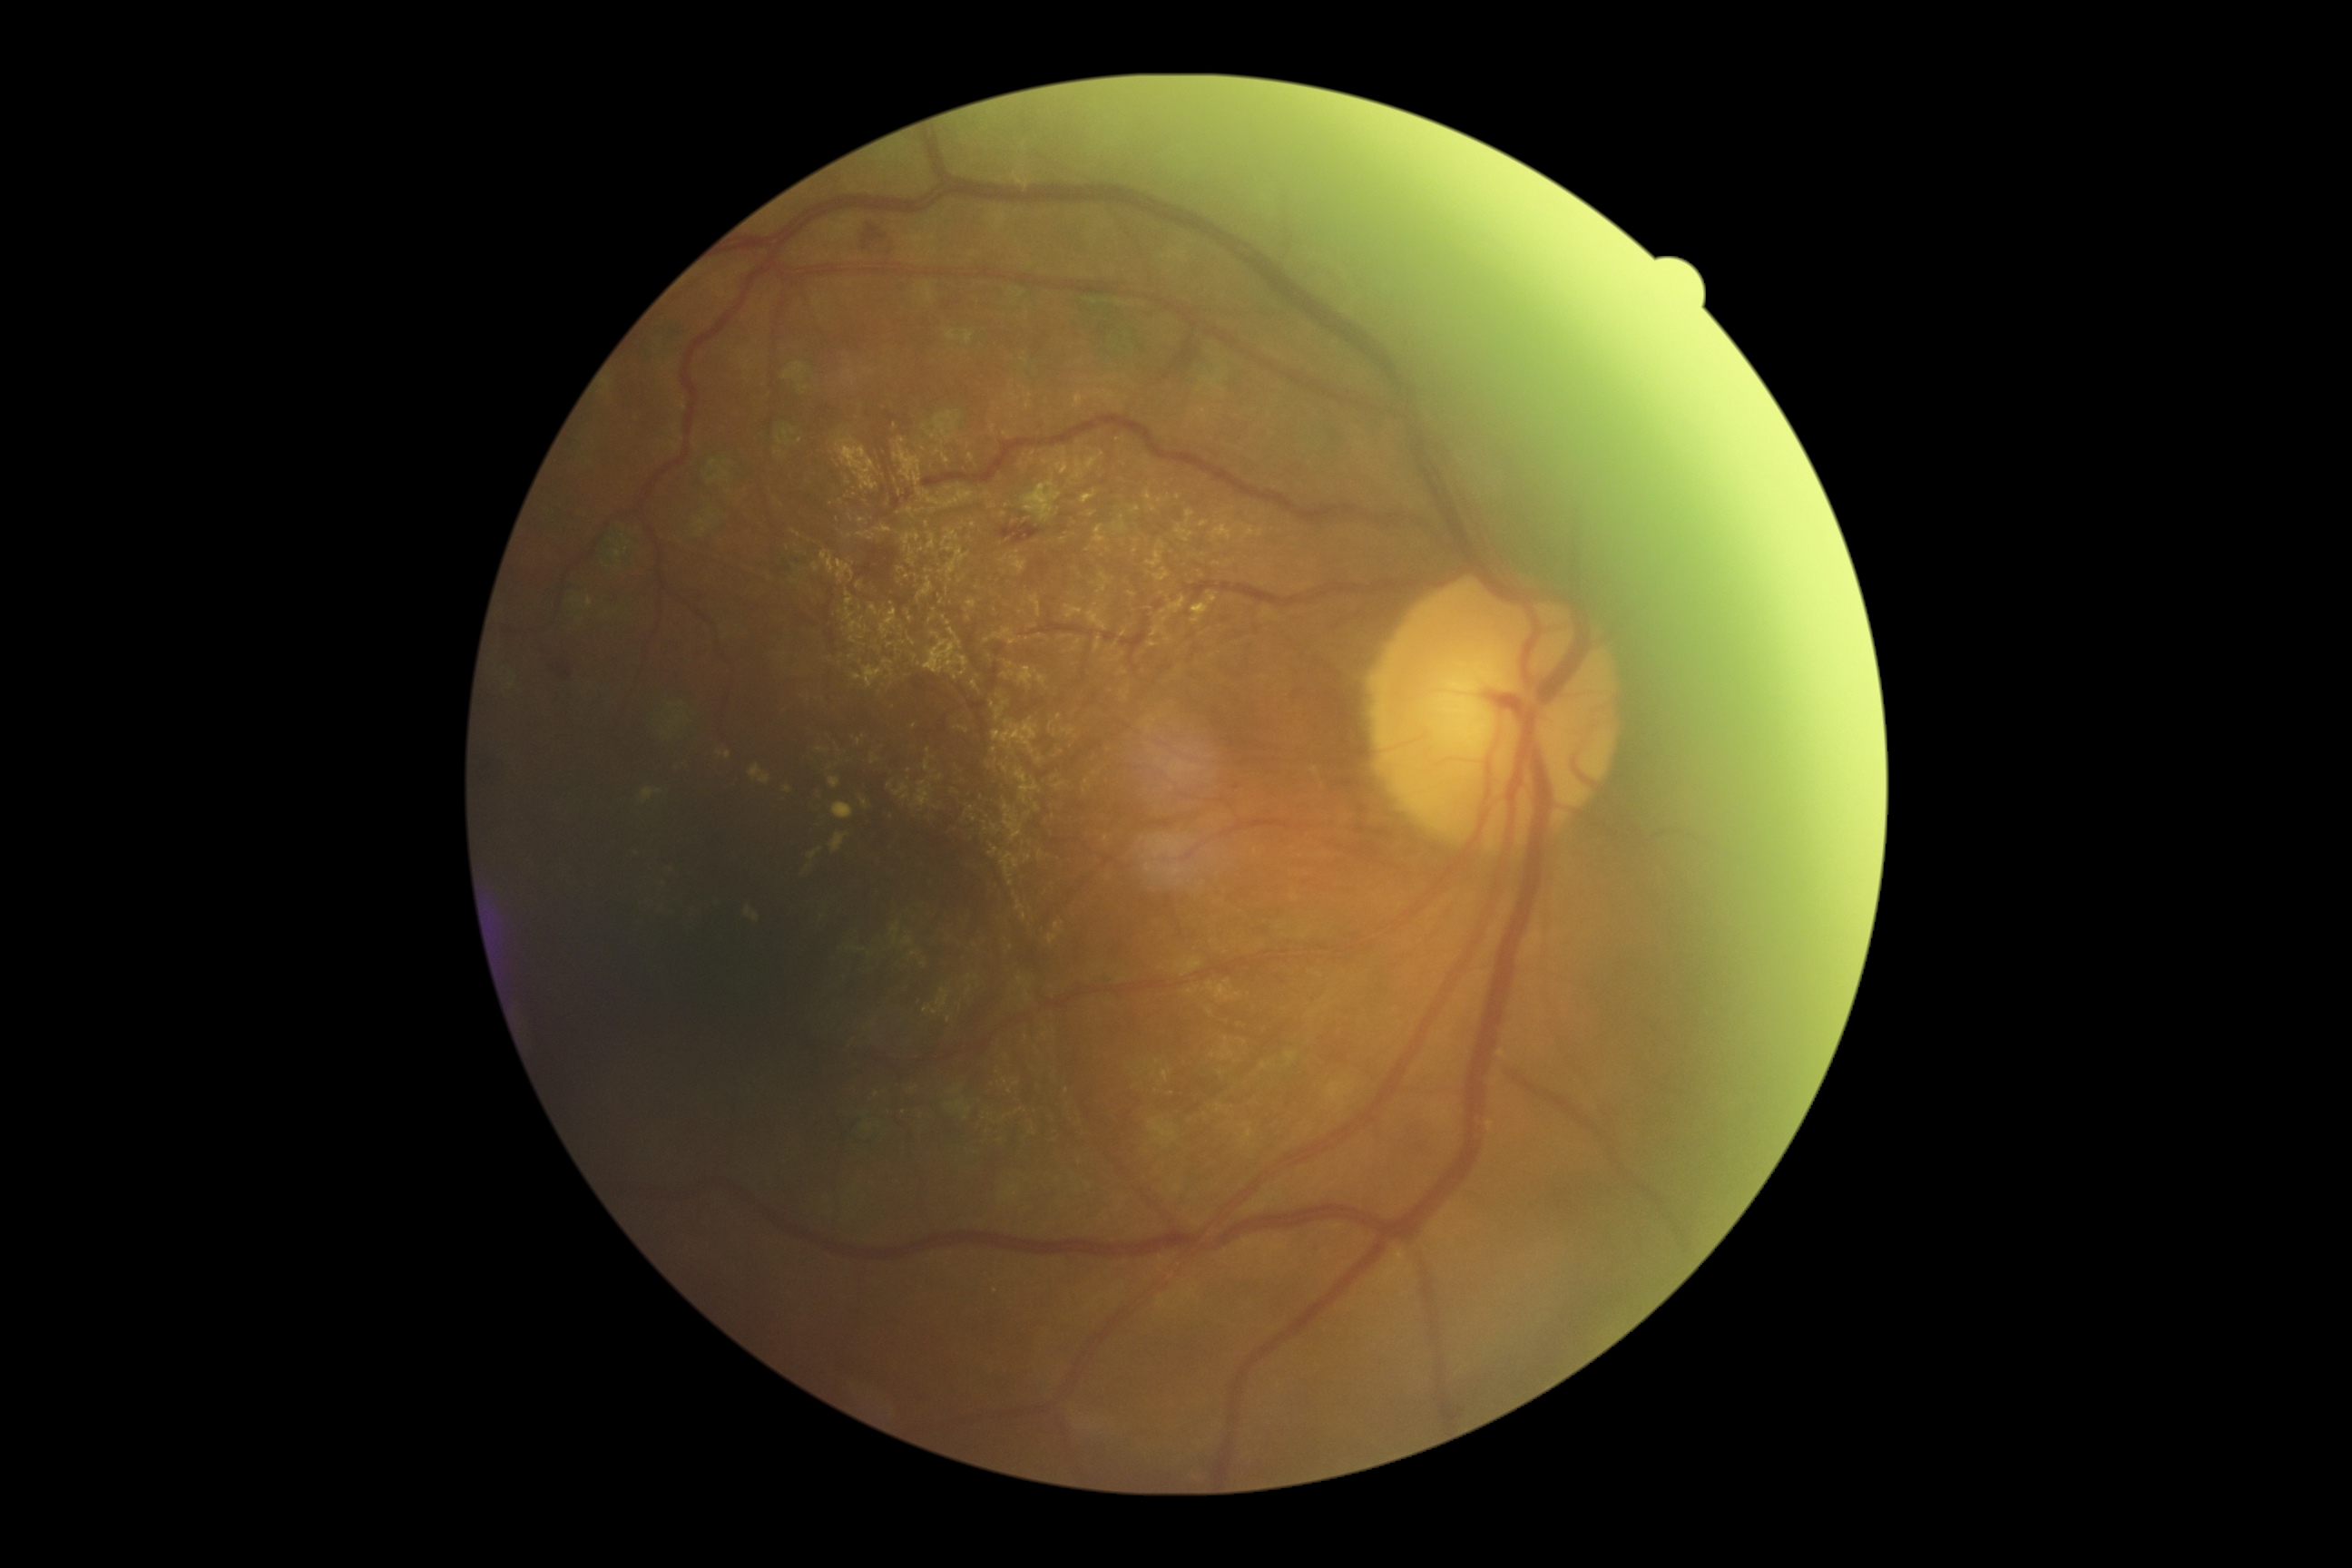
Annotations:
– DR: moderate non-proliferative diabetic retinopathy (grade 2) — more than just microaneurysms but less than severe NPDR